Wide-field contact fundus photograph of an infant.
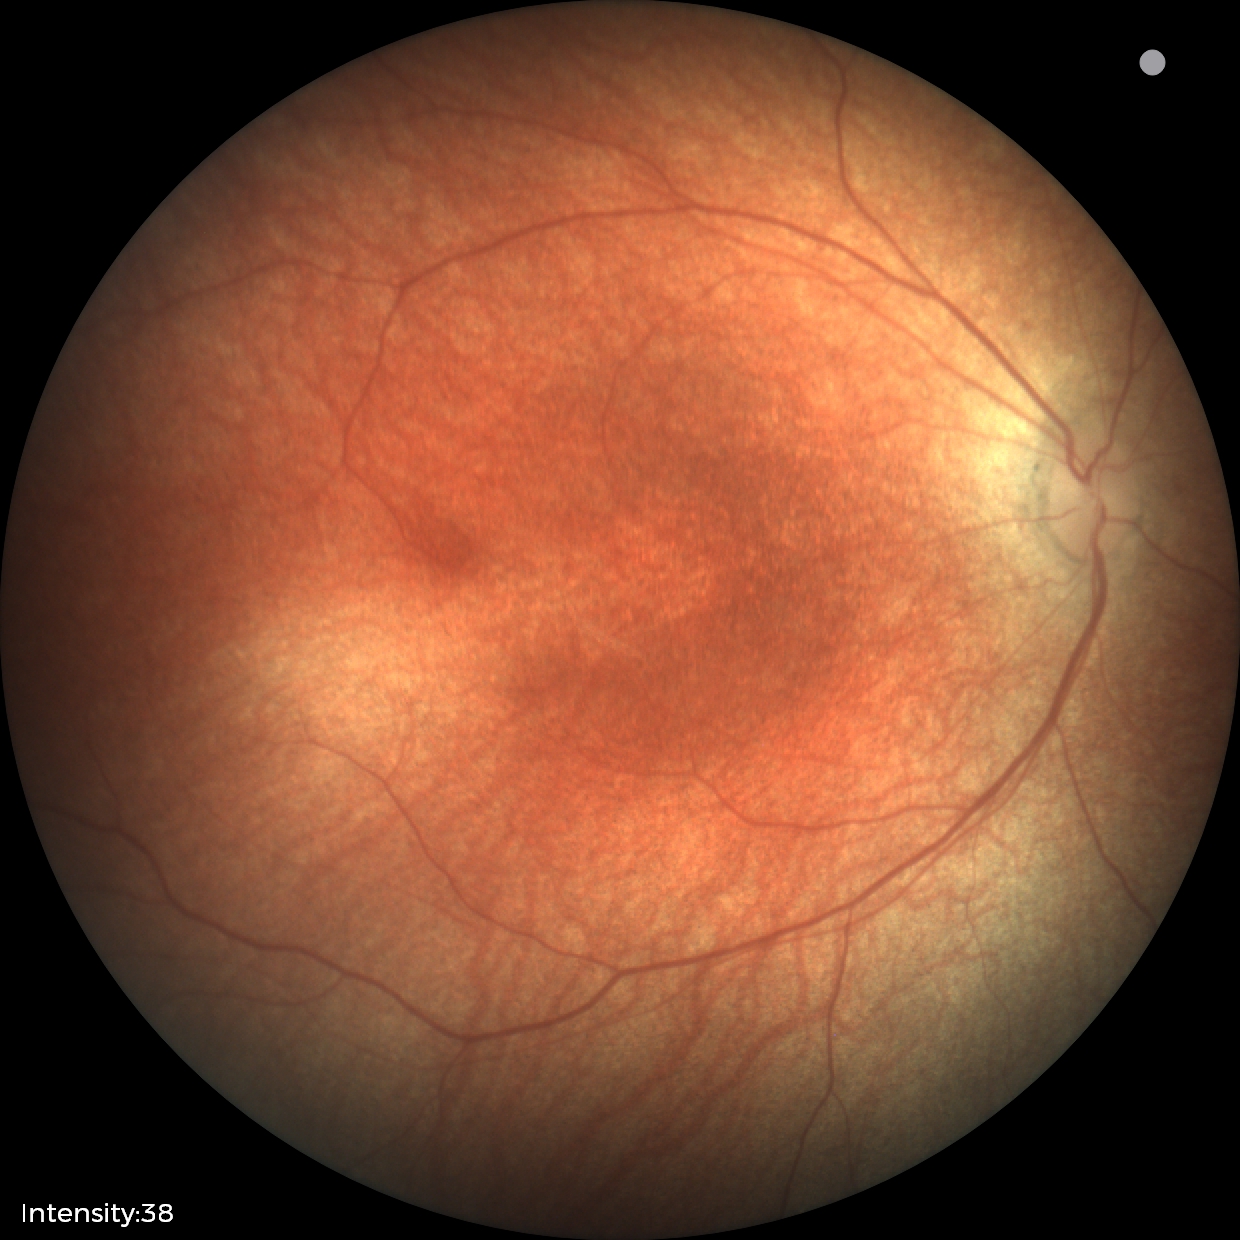

Q: What is the screening diagnosis?
A: physiological appearance with no retinal pathology